Infant wide-field retinal image
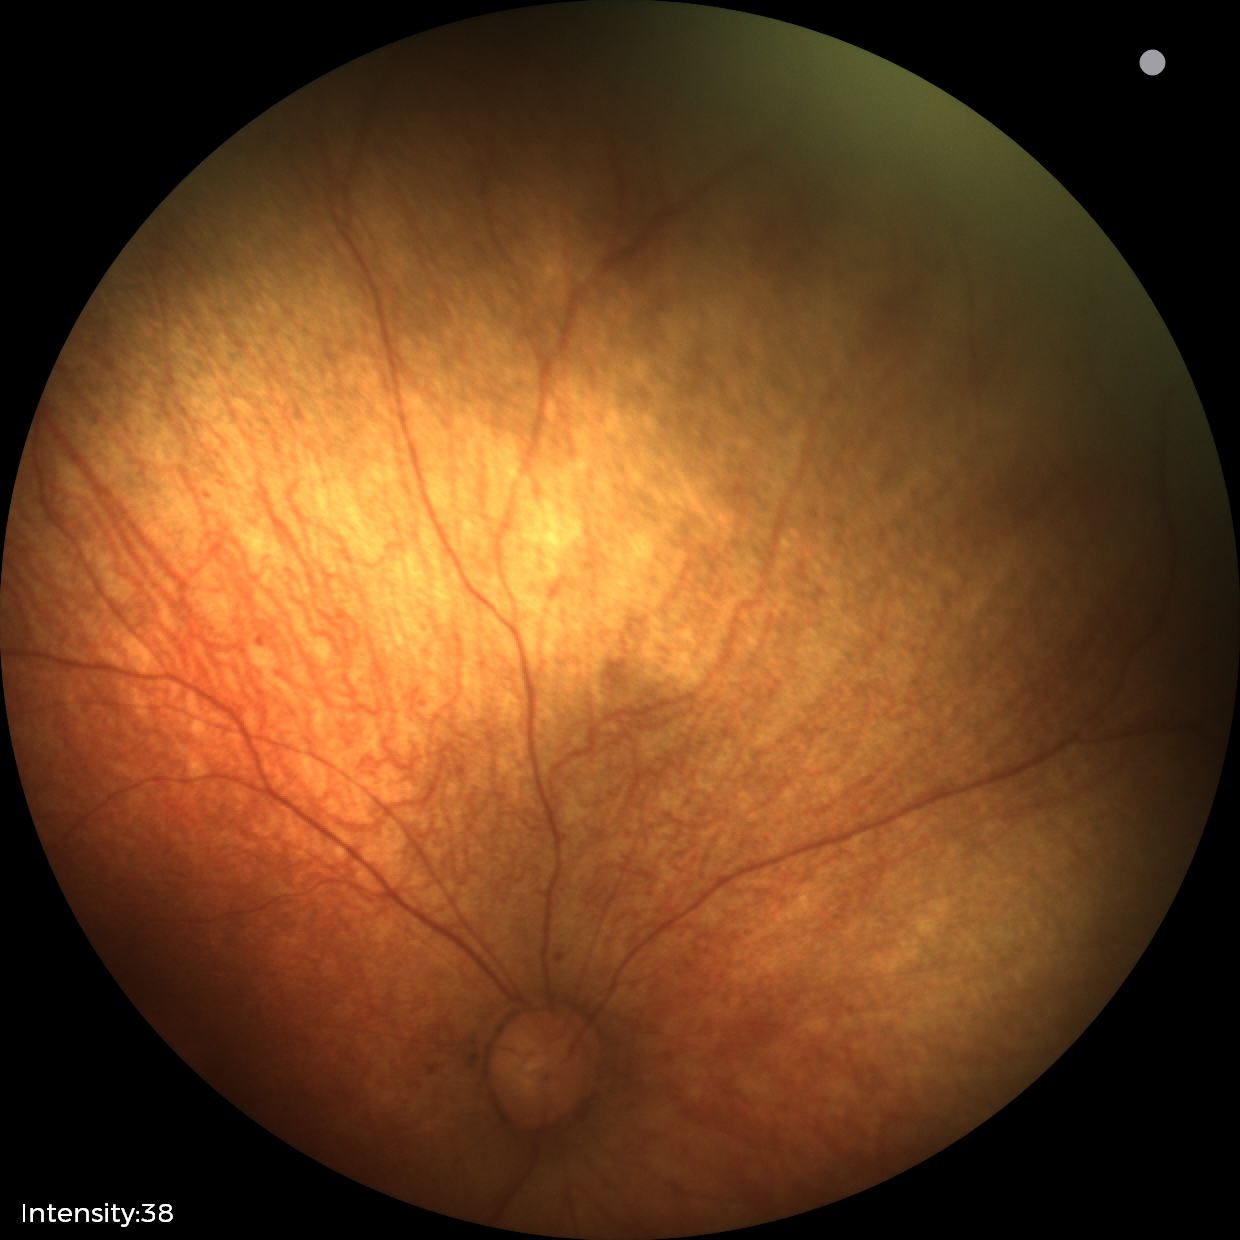
Examination with physiological retinal findings.